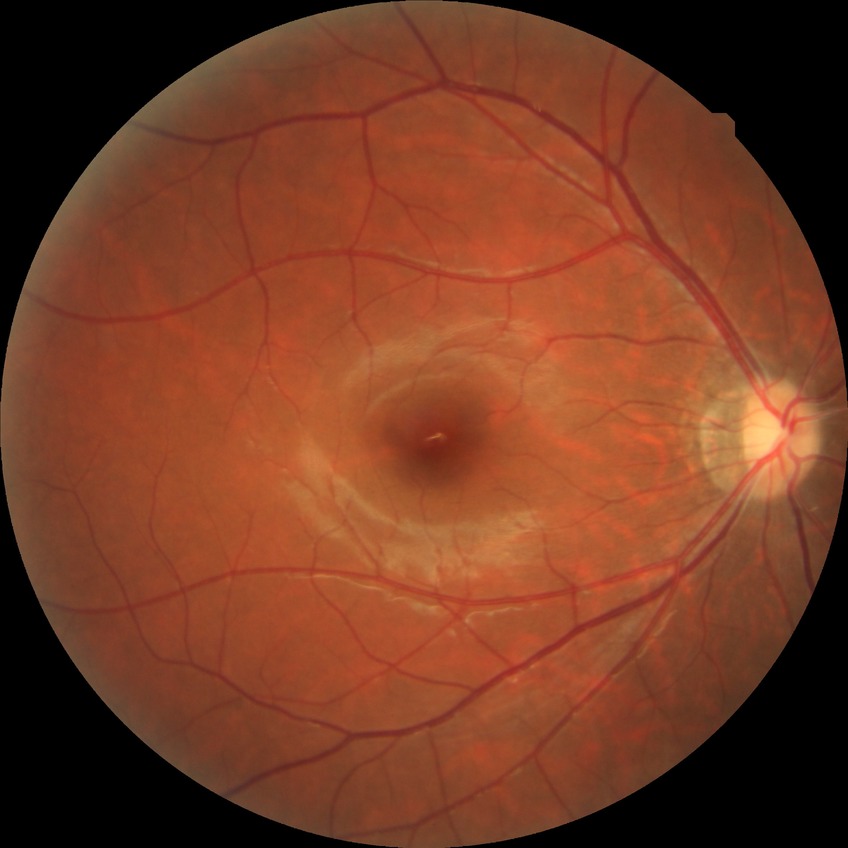 diabetic retinopathy stage = no diabetic retinopathy.